Modified Davis classification. Camera: NIDEK AFC-230. 848x848px. Posterior pole color fundus photograph:
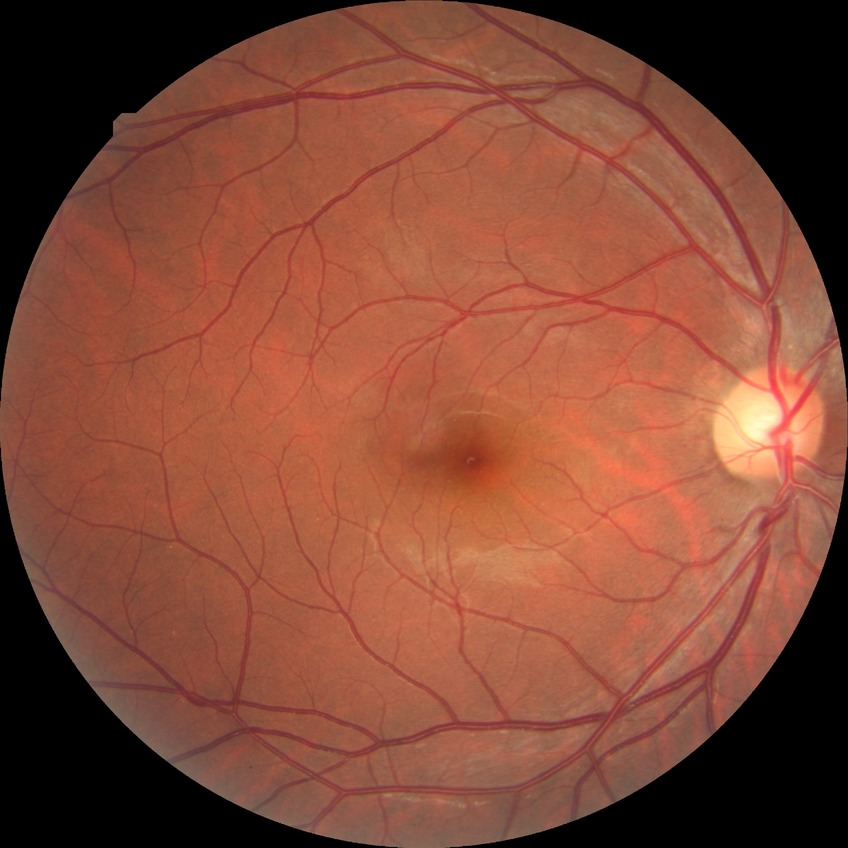

Annotations:
* diabetic retinopathy severity — no diabetic retinopathy